Color fundus image; 1504 by 1000 pixels
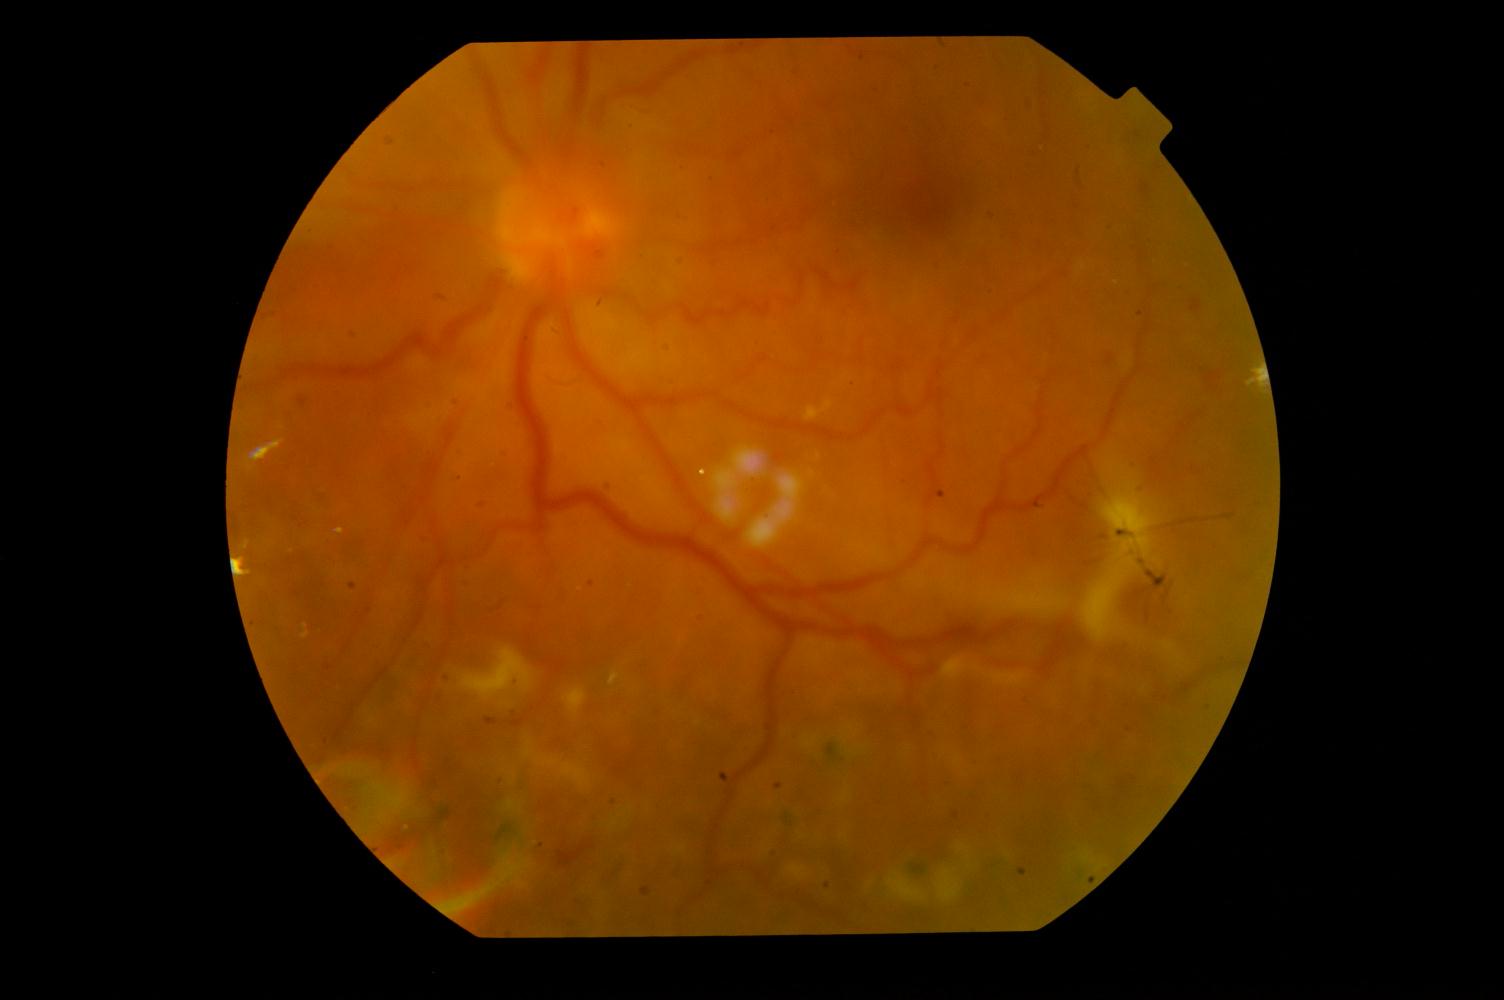

Findings:
- diabetic retinopathy (DR)